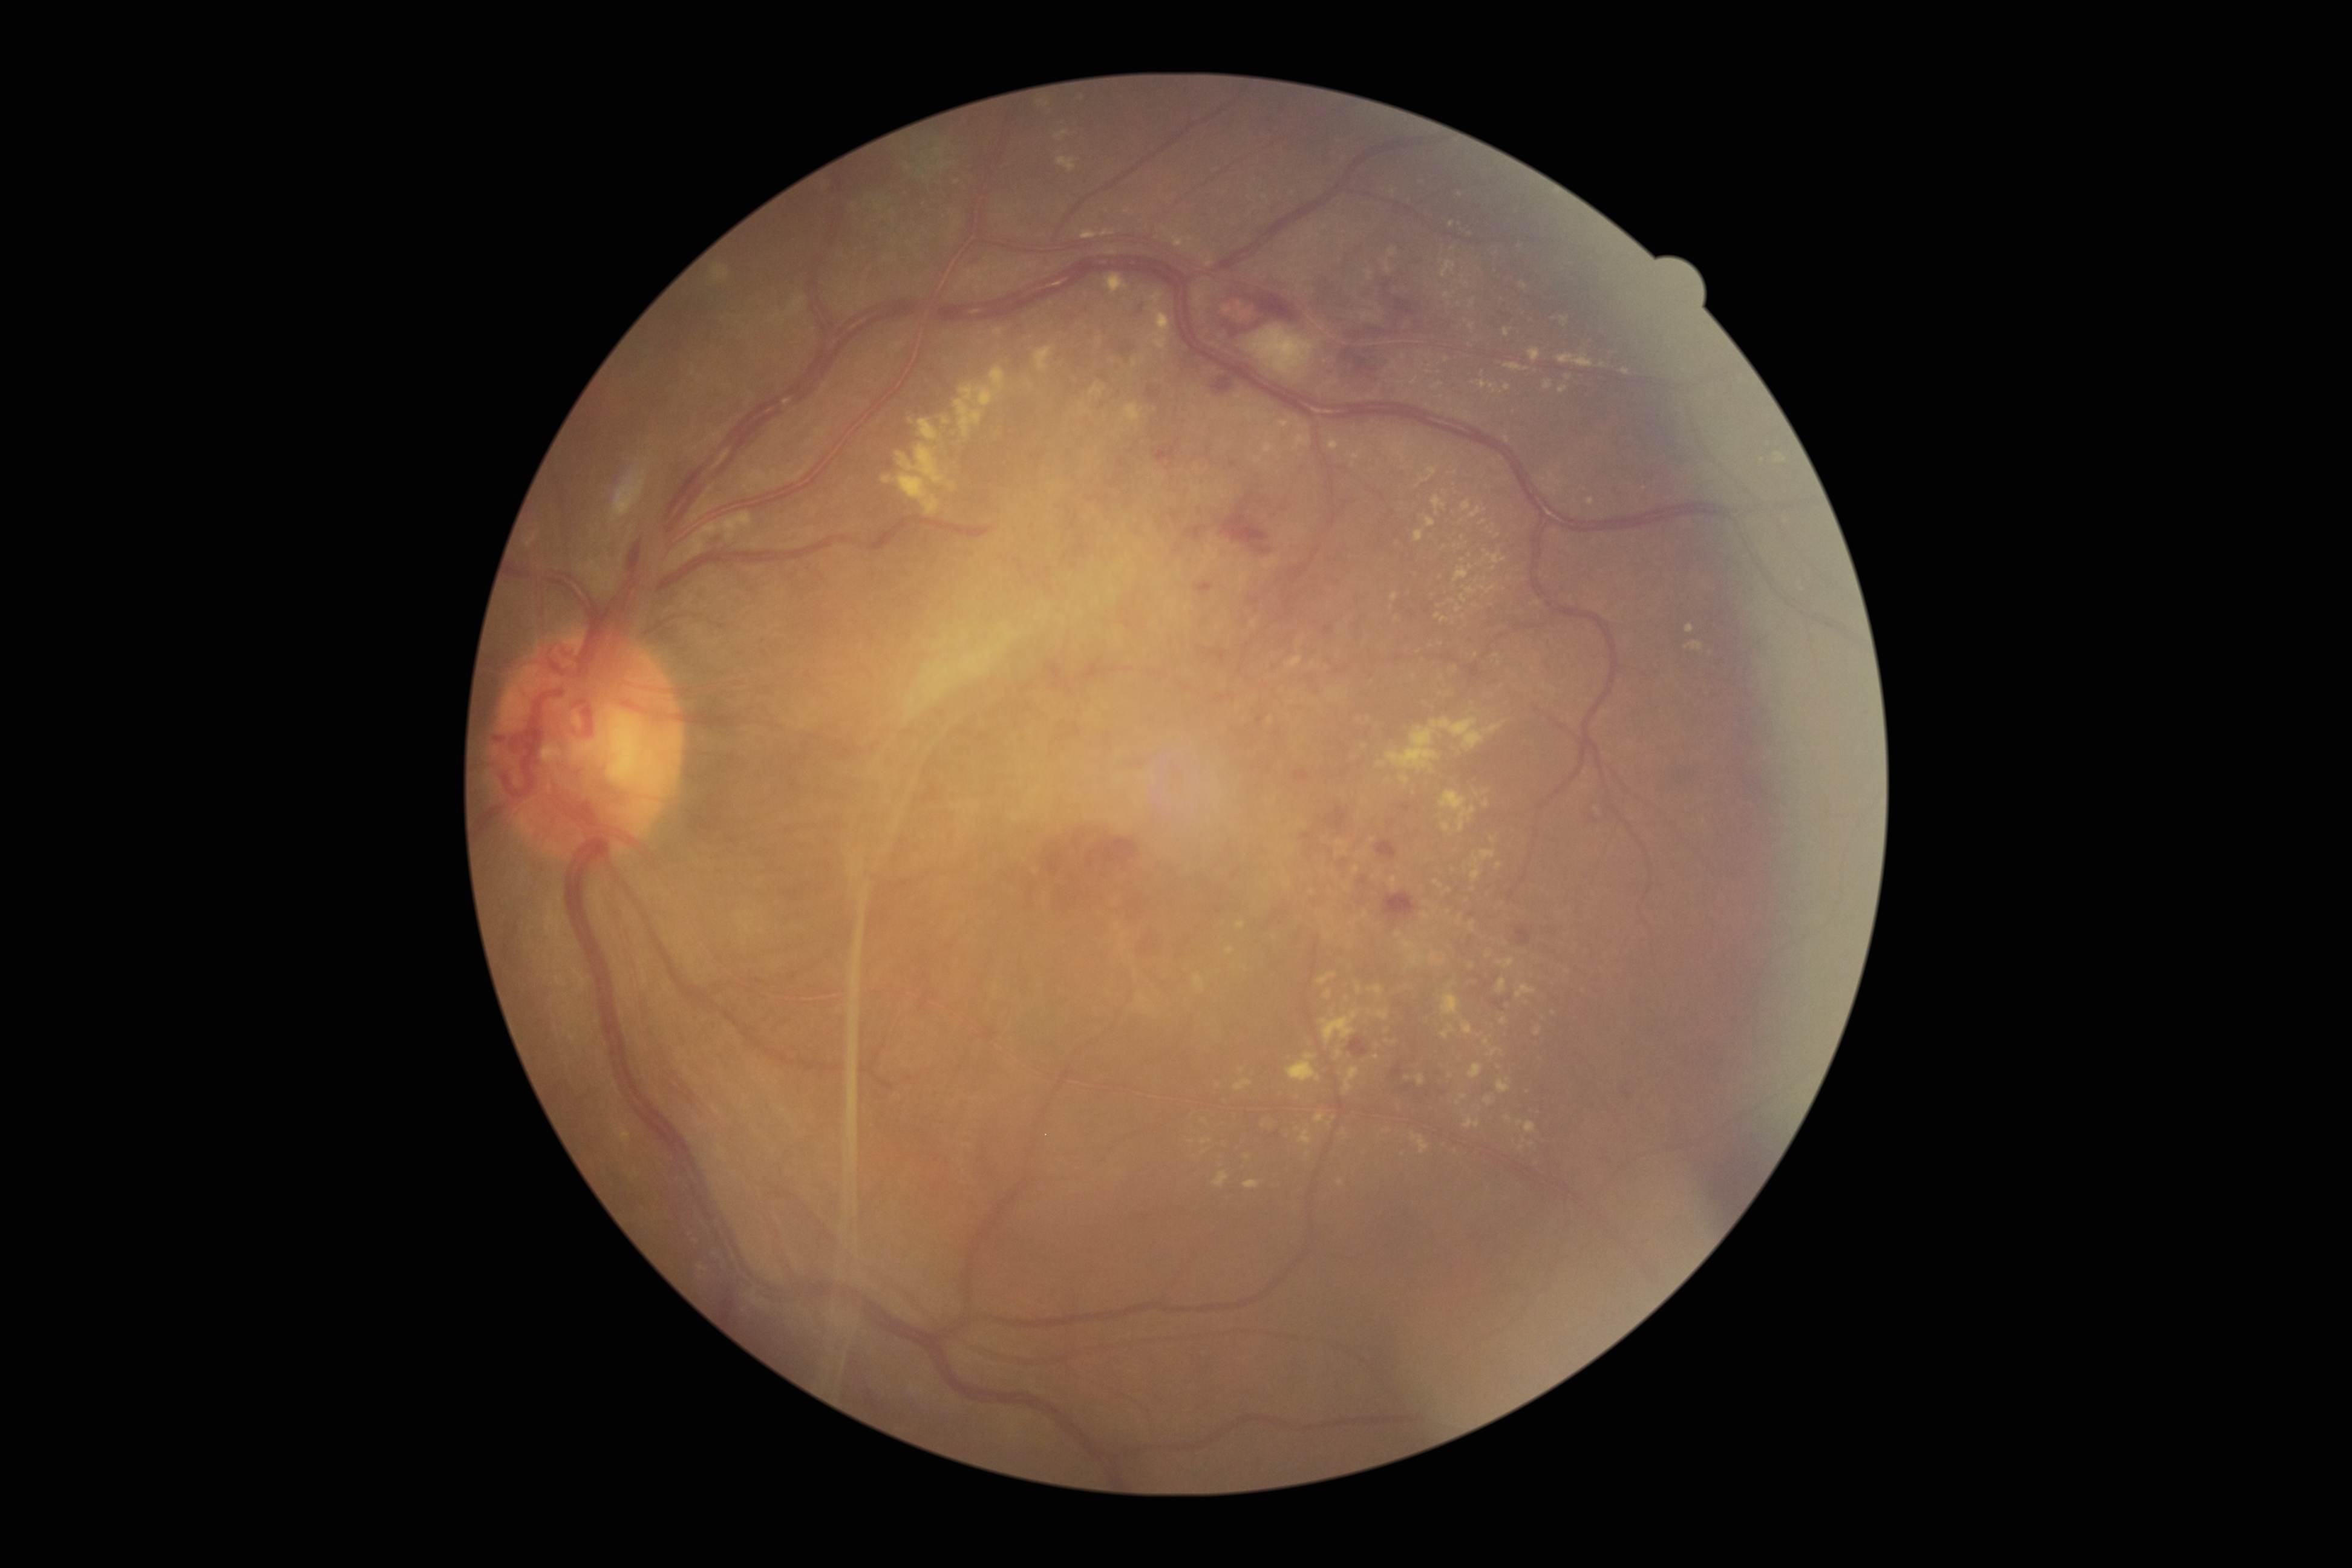
DR severity is PDR (grade 4)
Lesions identified (partial list):
* EXs (subset): 1469:506:1485:518 | 1558:354:1594:367 | 1255:457:1263:463 | 1037:101:1046:108 | 1466:587:1477:595 | 1138:995:1148:1006 | 1194:975:1206:993 | 1504:385:1512:391 | 1529:349:1541:361 | 1442:822:1451:832 | 1442:260:1457:278 | 1386:718:1485:773
* EXs (small, approximate centers) near {"x": 1393, "y": 253} | {"x": 1403, "y": 357} | {"x": 1333, "y": 1013} | {"x": 1486, "y": 791} | {"x": 1442, "y": 605} | {"x": 1431, "y": 646} | {"x": 1452, "y": 249} | {"x": 1204, "y": 1152}
* SEs: 1244:324:1322:377
* HEs (subset): 1103:333:1135:360 | 1208:650:1226:664 | 1134:303:1144:315 | 1213:295:1300:335 | 1358:878:1367:885 | 1329:806:1348:831 | 705:534:720:545 | 1622:1091:1634:1110 | 1221:505:1273:555 | 1319:652:1336:664 | 1212:377:1233:394 | 1183:527:1203:539 | 1348:351:1385:387 | 1301:833:1315:840 | 1350:1037:1368:1056 | 1405:1085:1432:1099 | 1156:452:1165:460
* HEs (small, approximate centers) near {"x": 1233, "y": 465} | {"x": 1253, "y": 494}
* MAs: 1154:452:1165:459 | 1231:462:1238:470